Color fundus photograph · 45-degree field of view
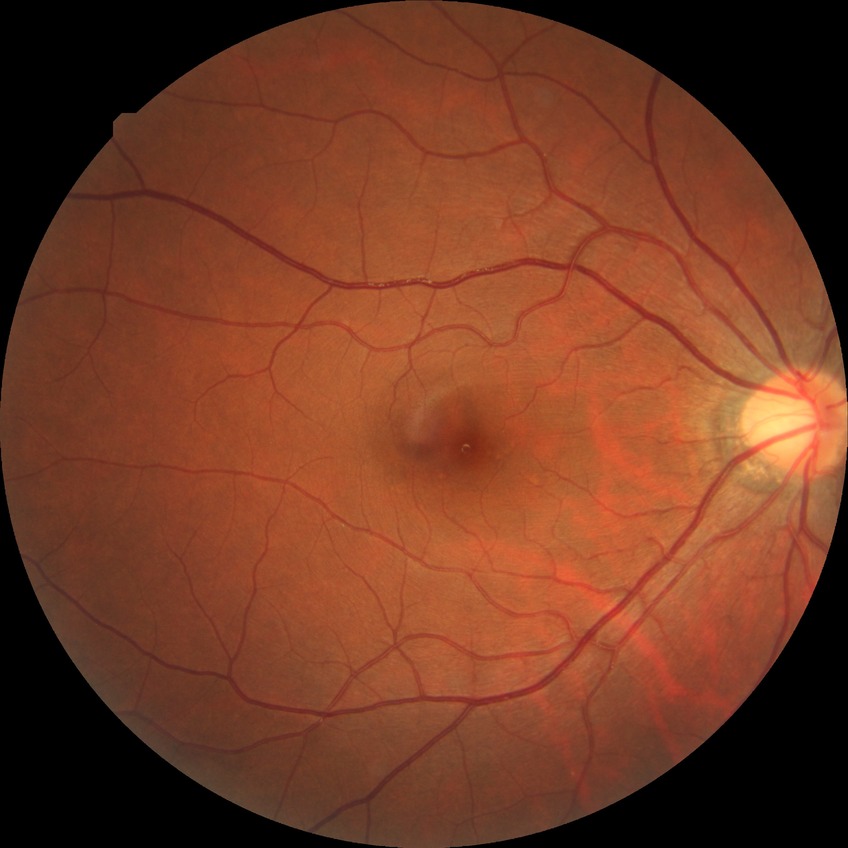

Diabetic retinopathy (DR) is no diabetic retinopathy (NDR).